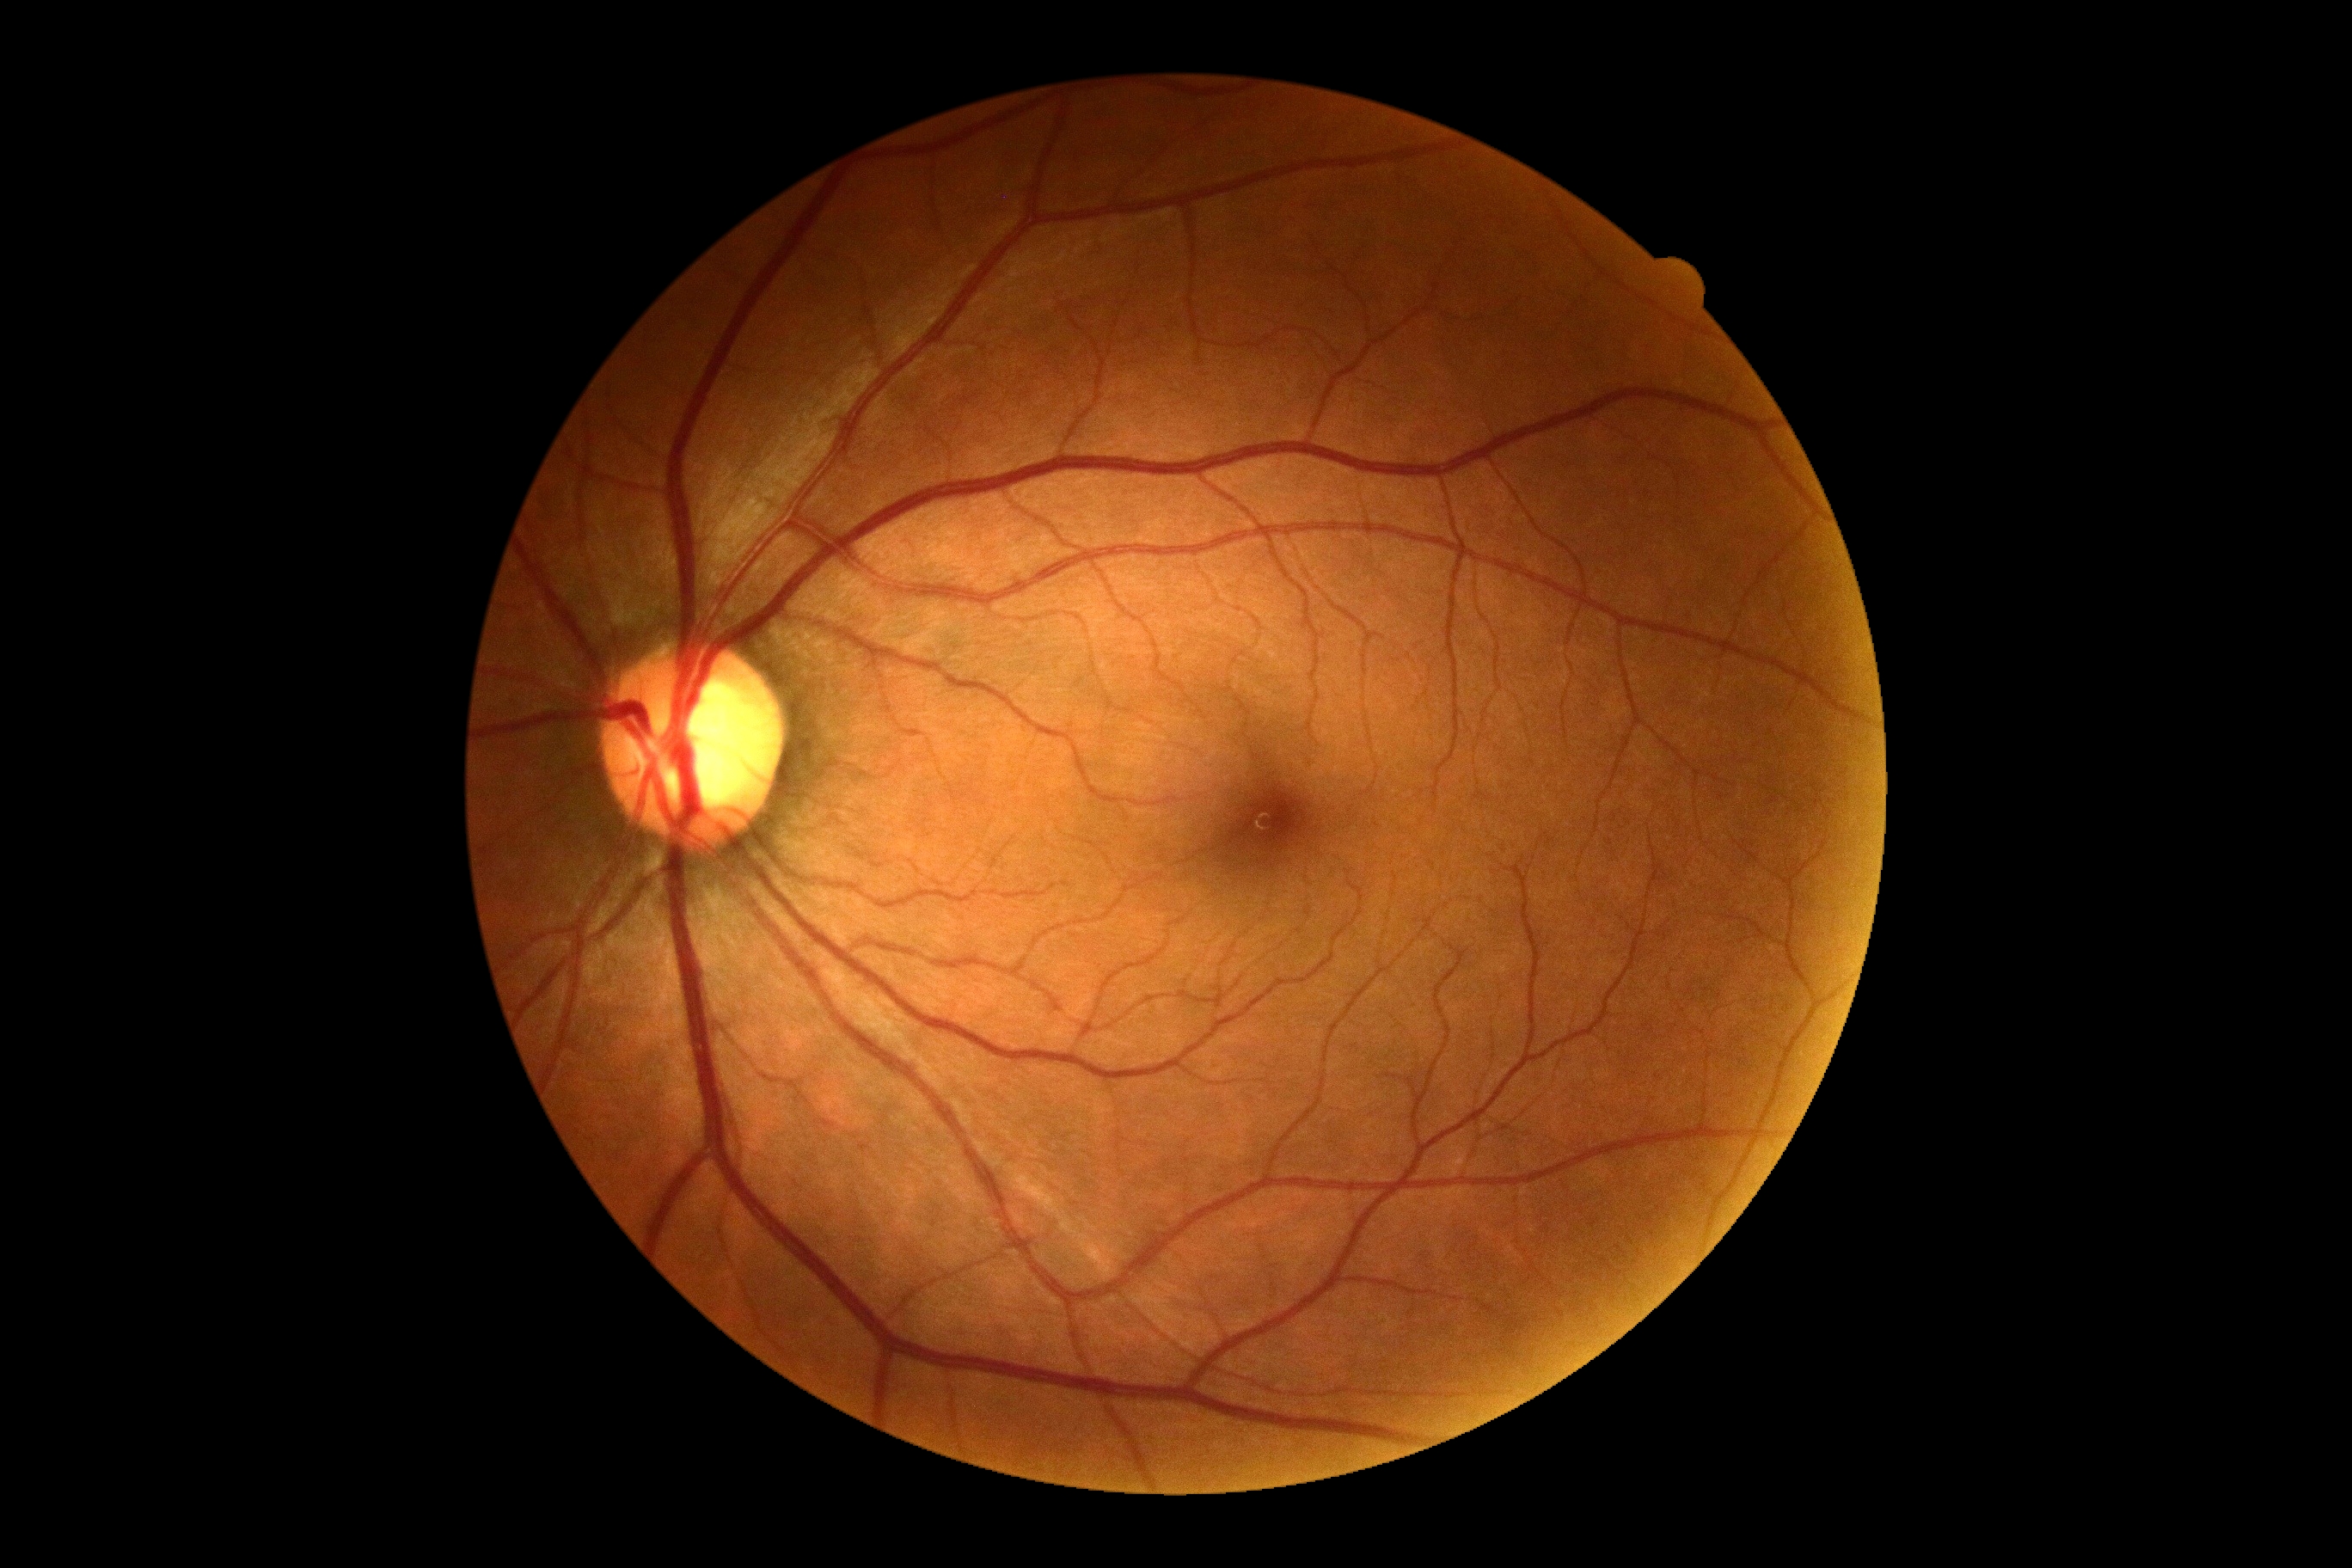

diabetic retinopathy (DR)=no apparent retinopathy (grade 0).